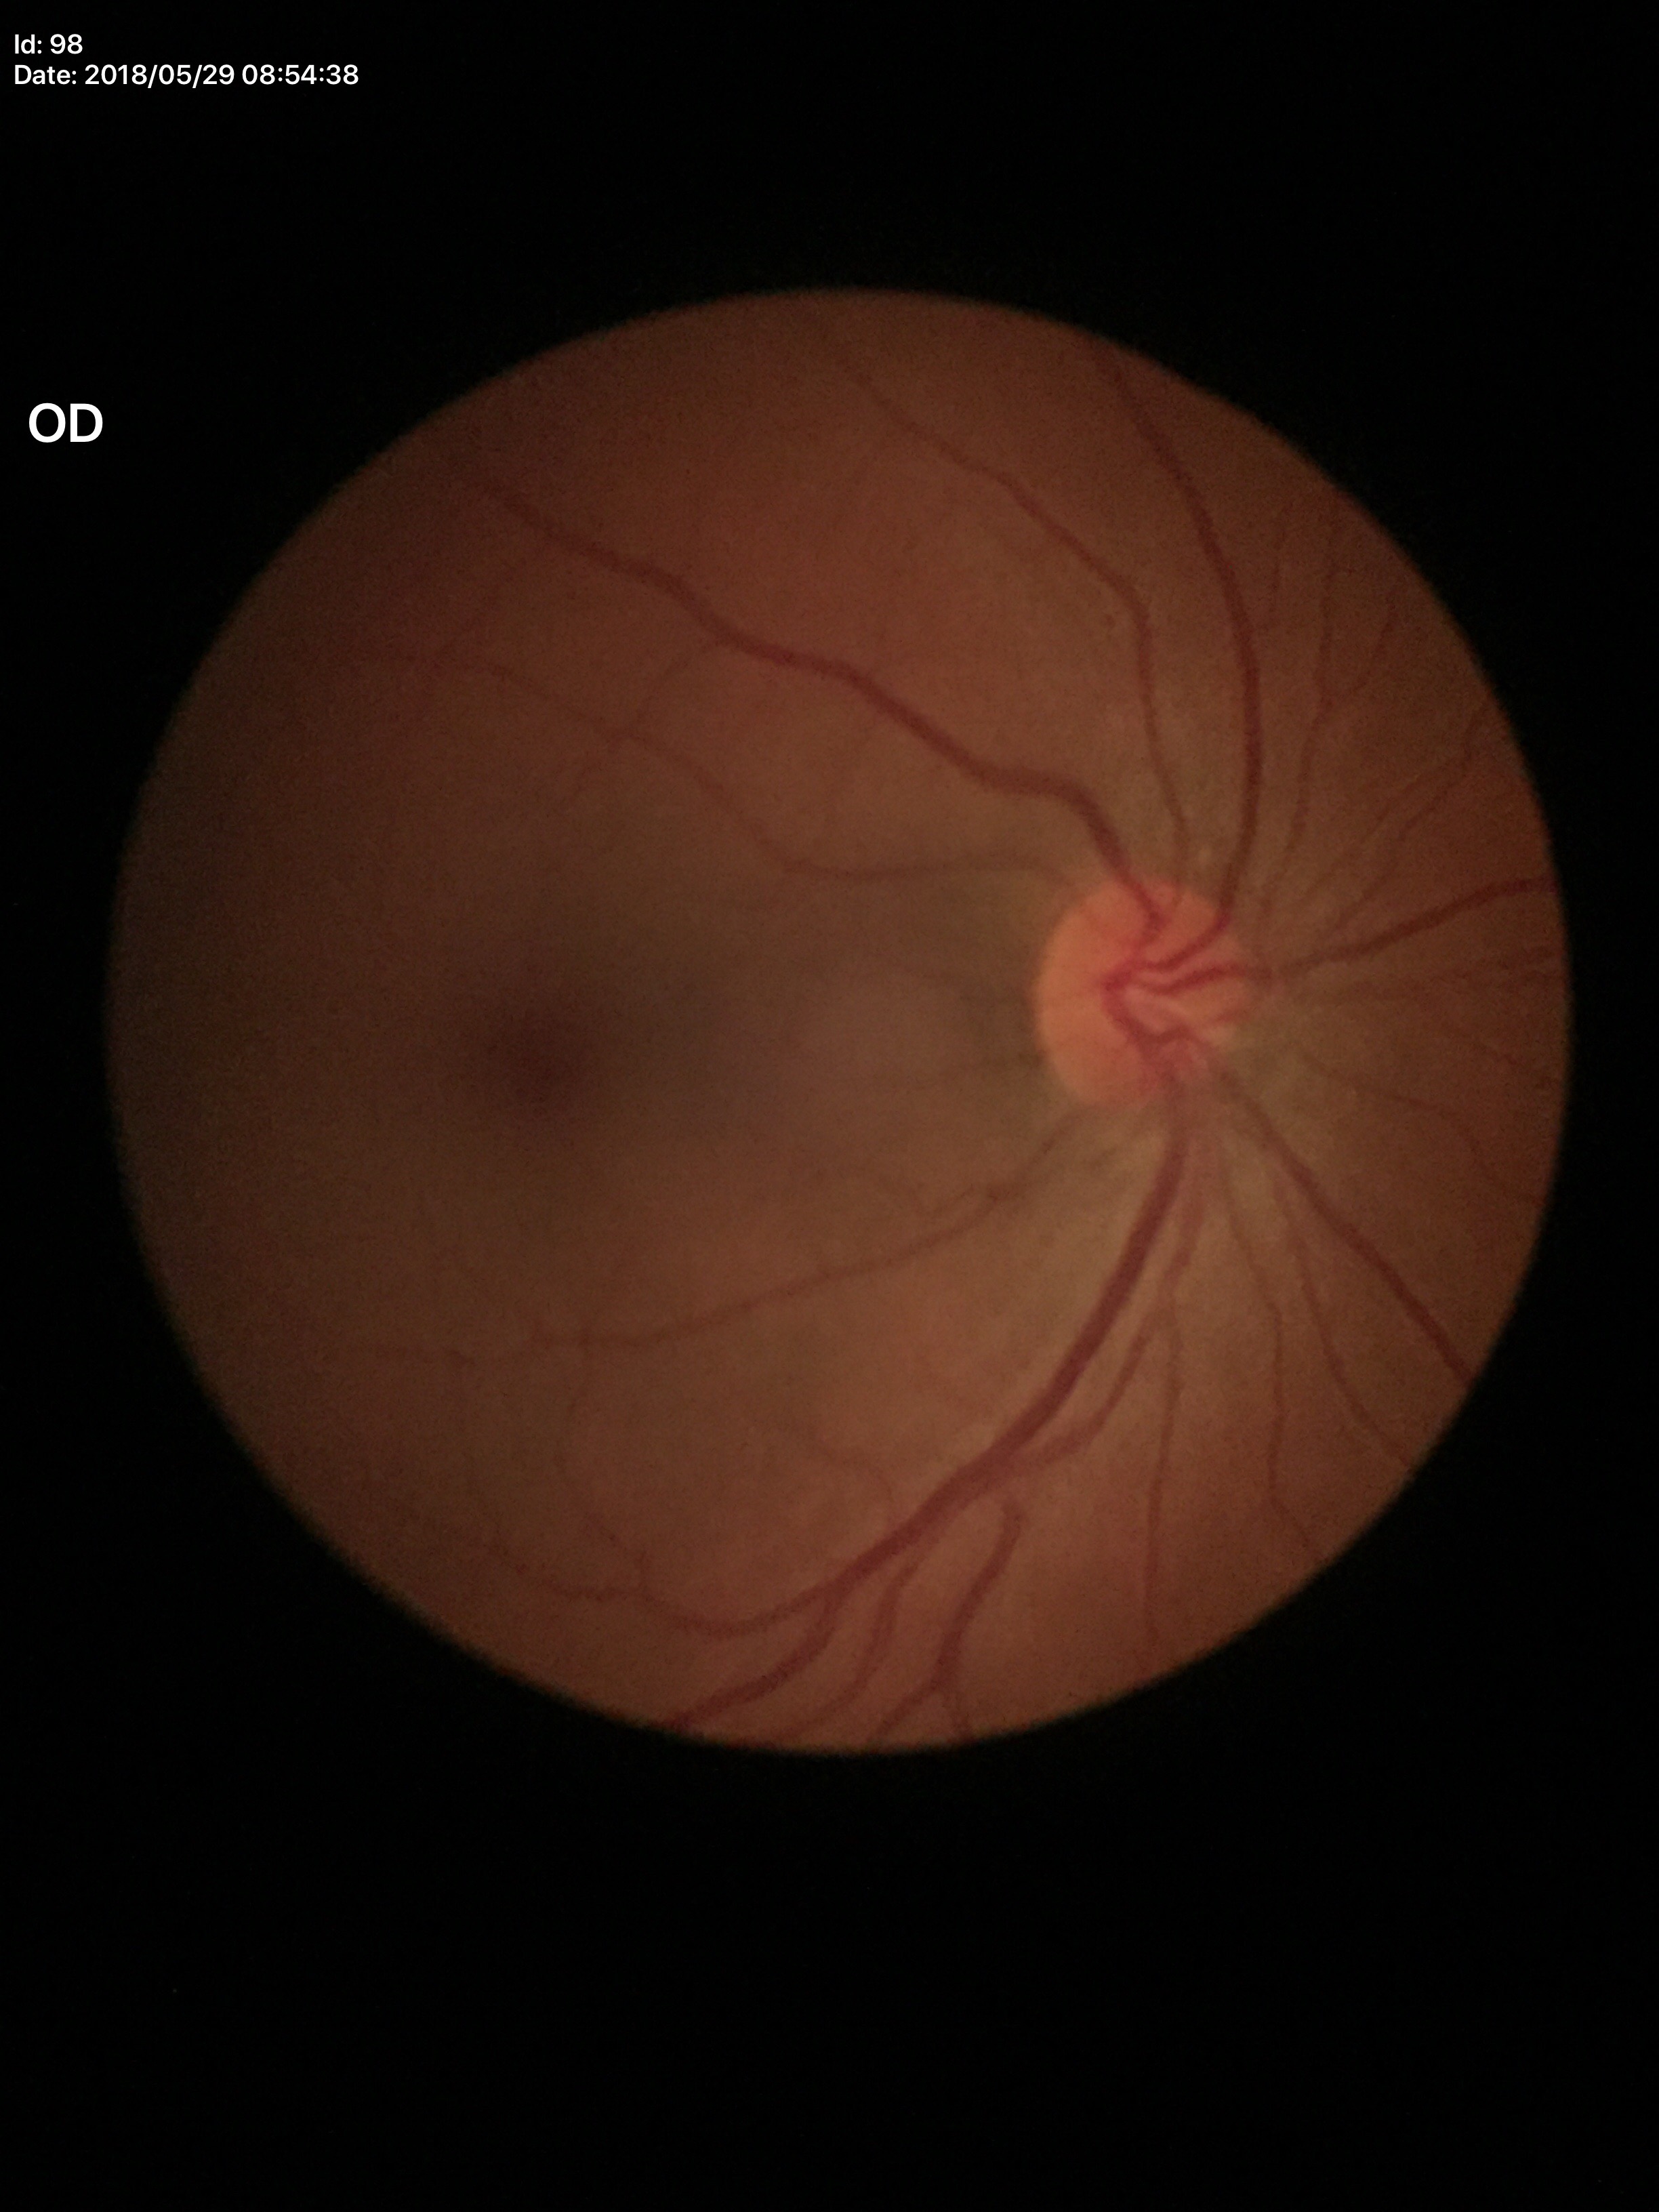 No glaucomatous findings. Vertical C/D ratio (VCDR): 0.42.